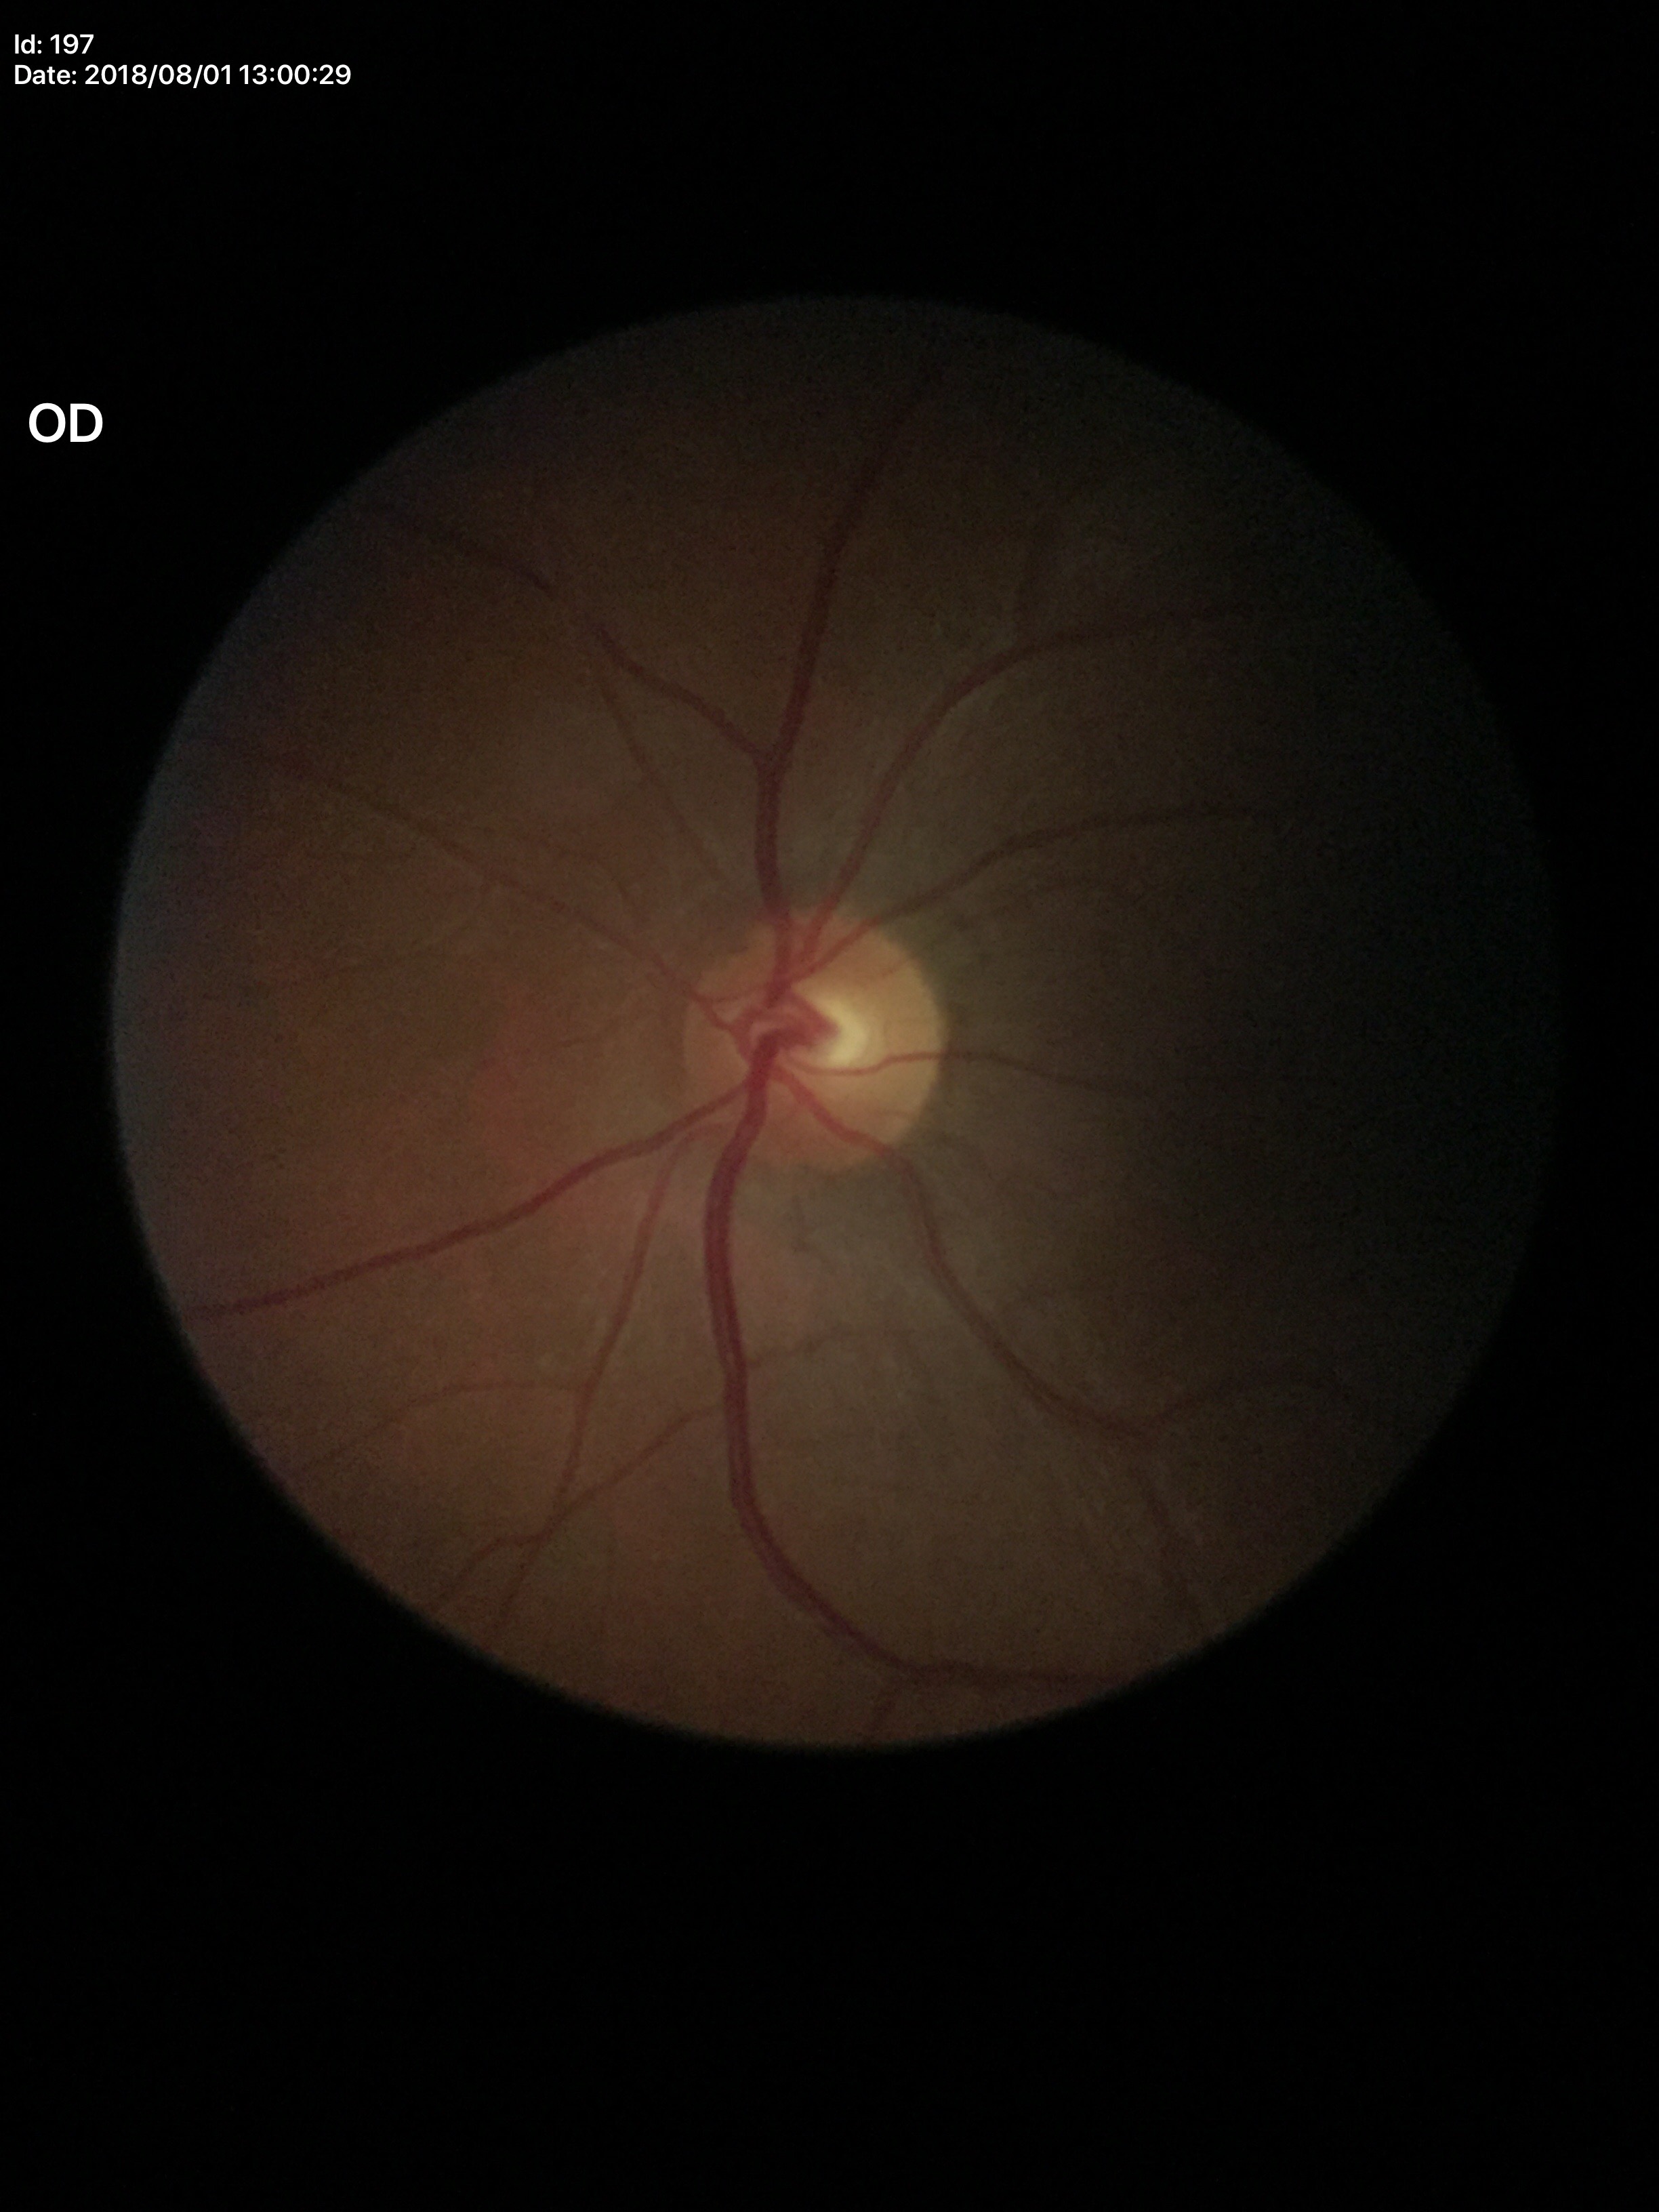 Glaucoma screening: no suspicious findings (1 of 5 graders flagged glaucoma suspect) | vertical cup-disc ratio: 0.50 | horizontal C/D ratio: 0.54.